2352 x 1568 pixels: 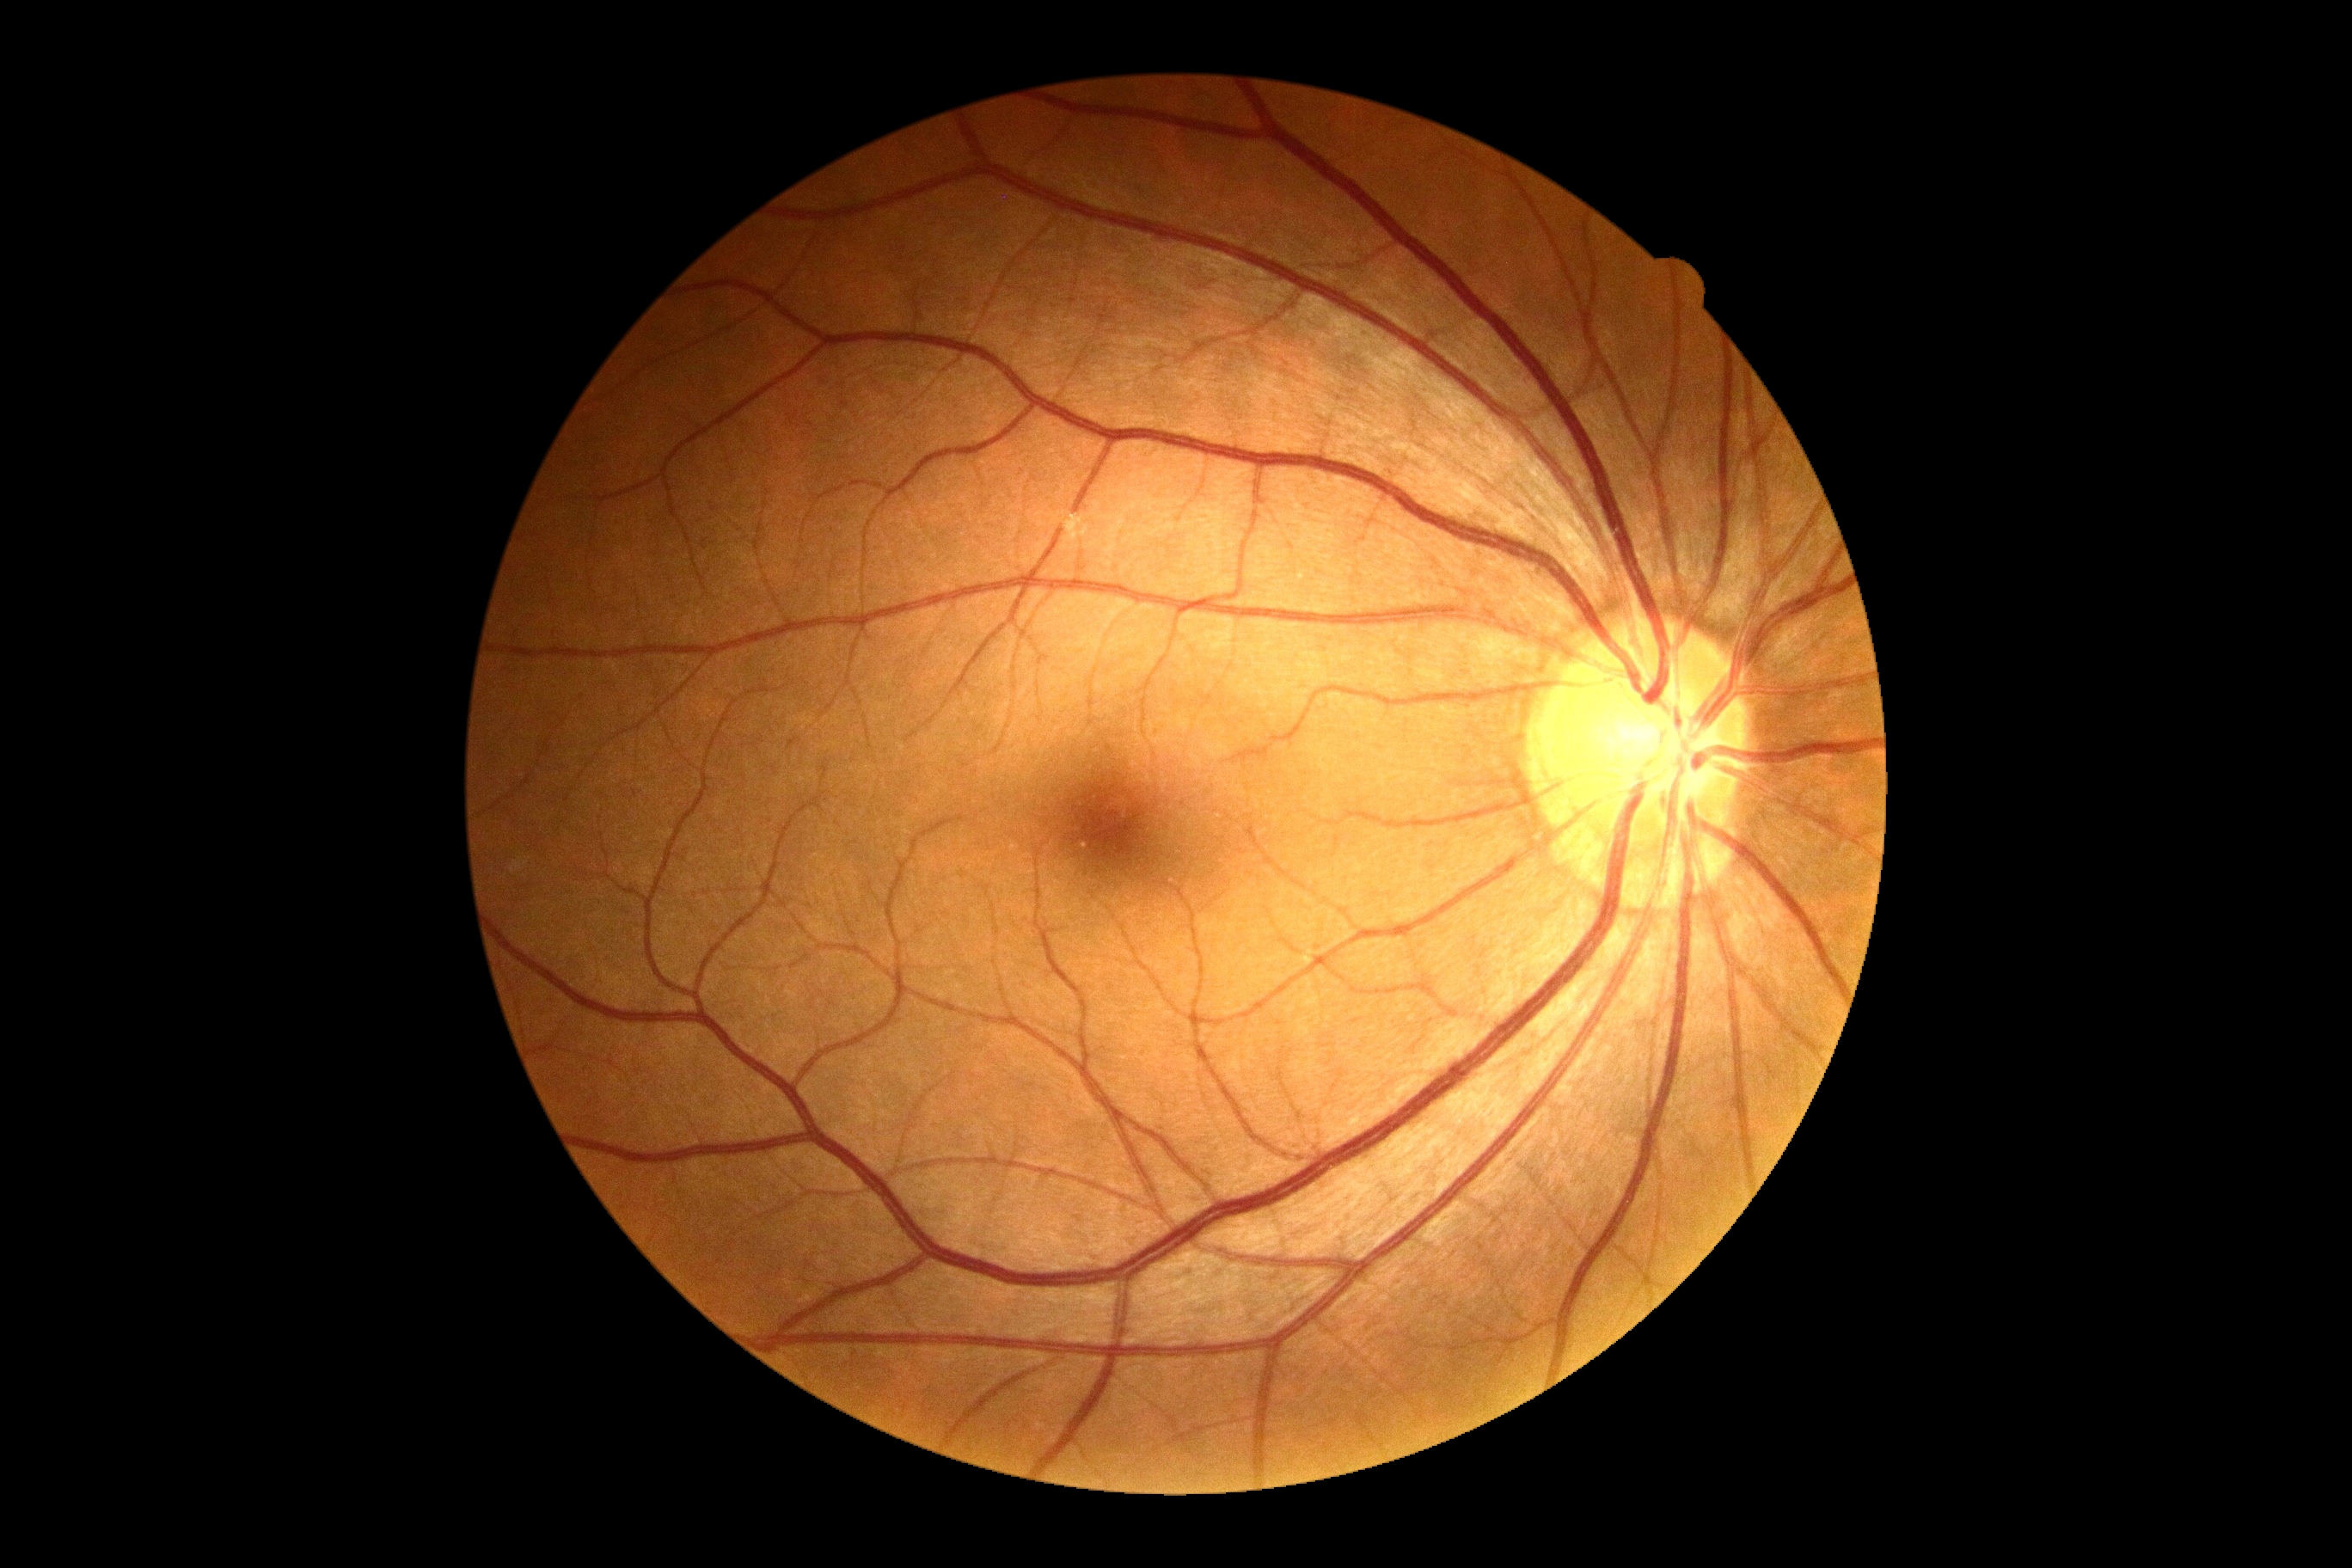
diabetic retinopathy (DR): 0/4; DR impression: no DR findings.